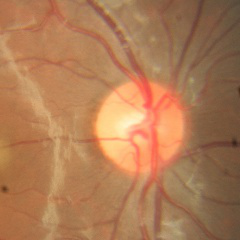

Fundus image with findings of no glaucomatous findings.